Diabetic retinopathy graded by the modified Davis classification
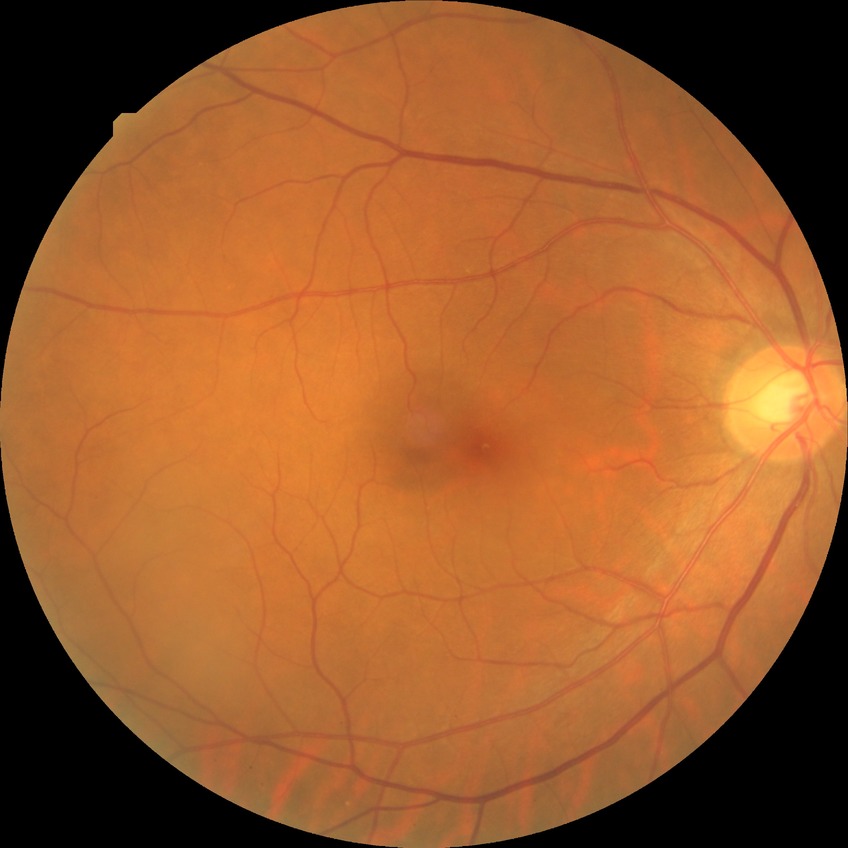

Diabetic retinopathy stage: no diabetic retinopathy.